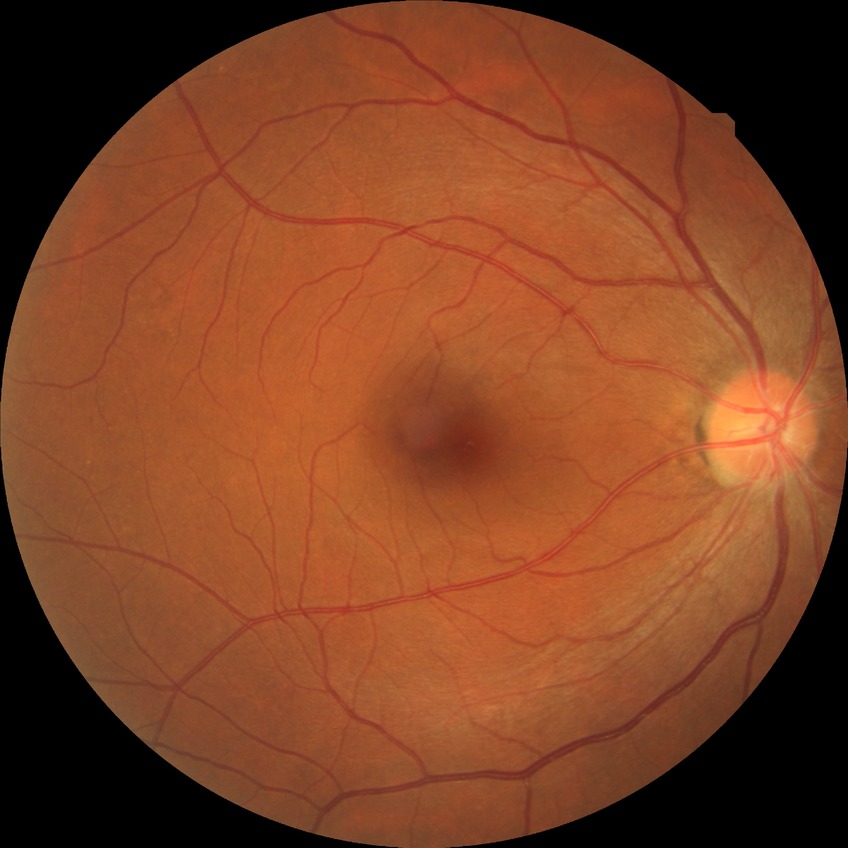

Findings:
- diabetic retinopathy (DR): no diabetic retinopathy (NDR)